Color fundus photograph
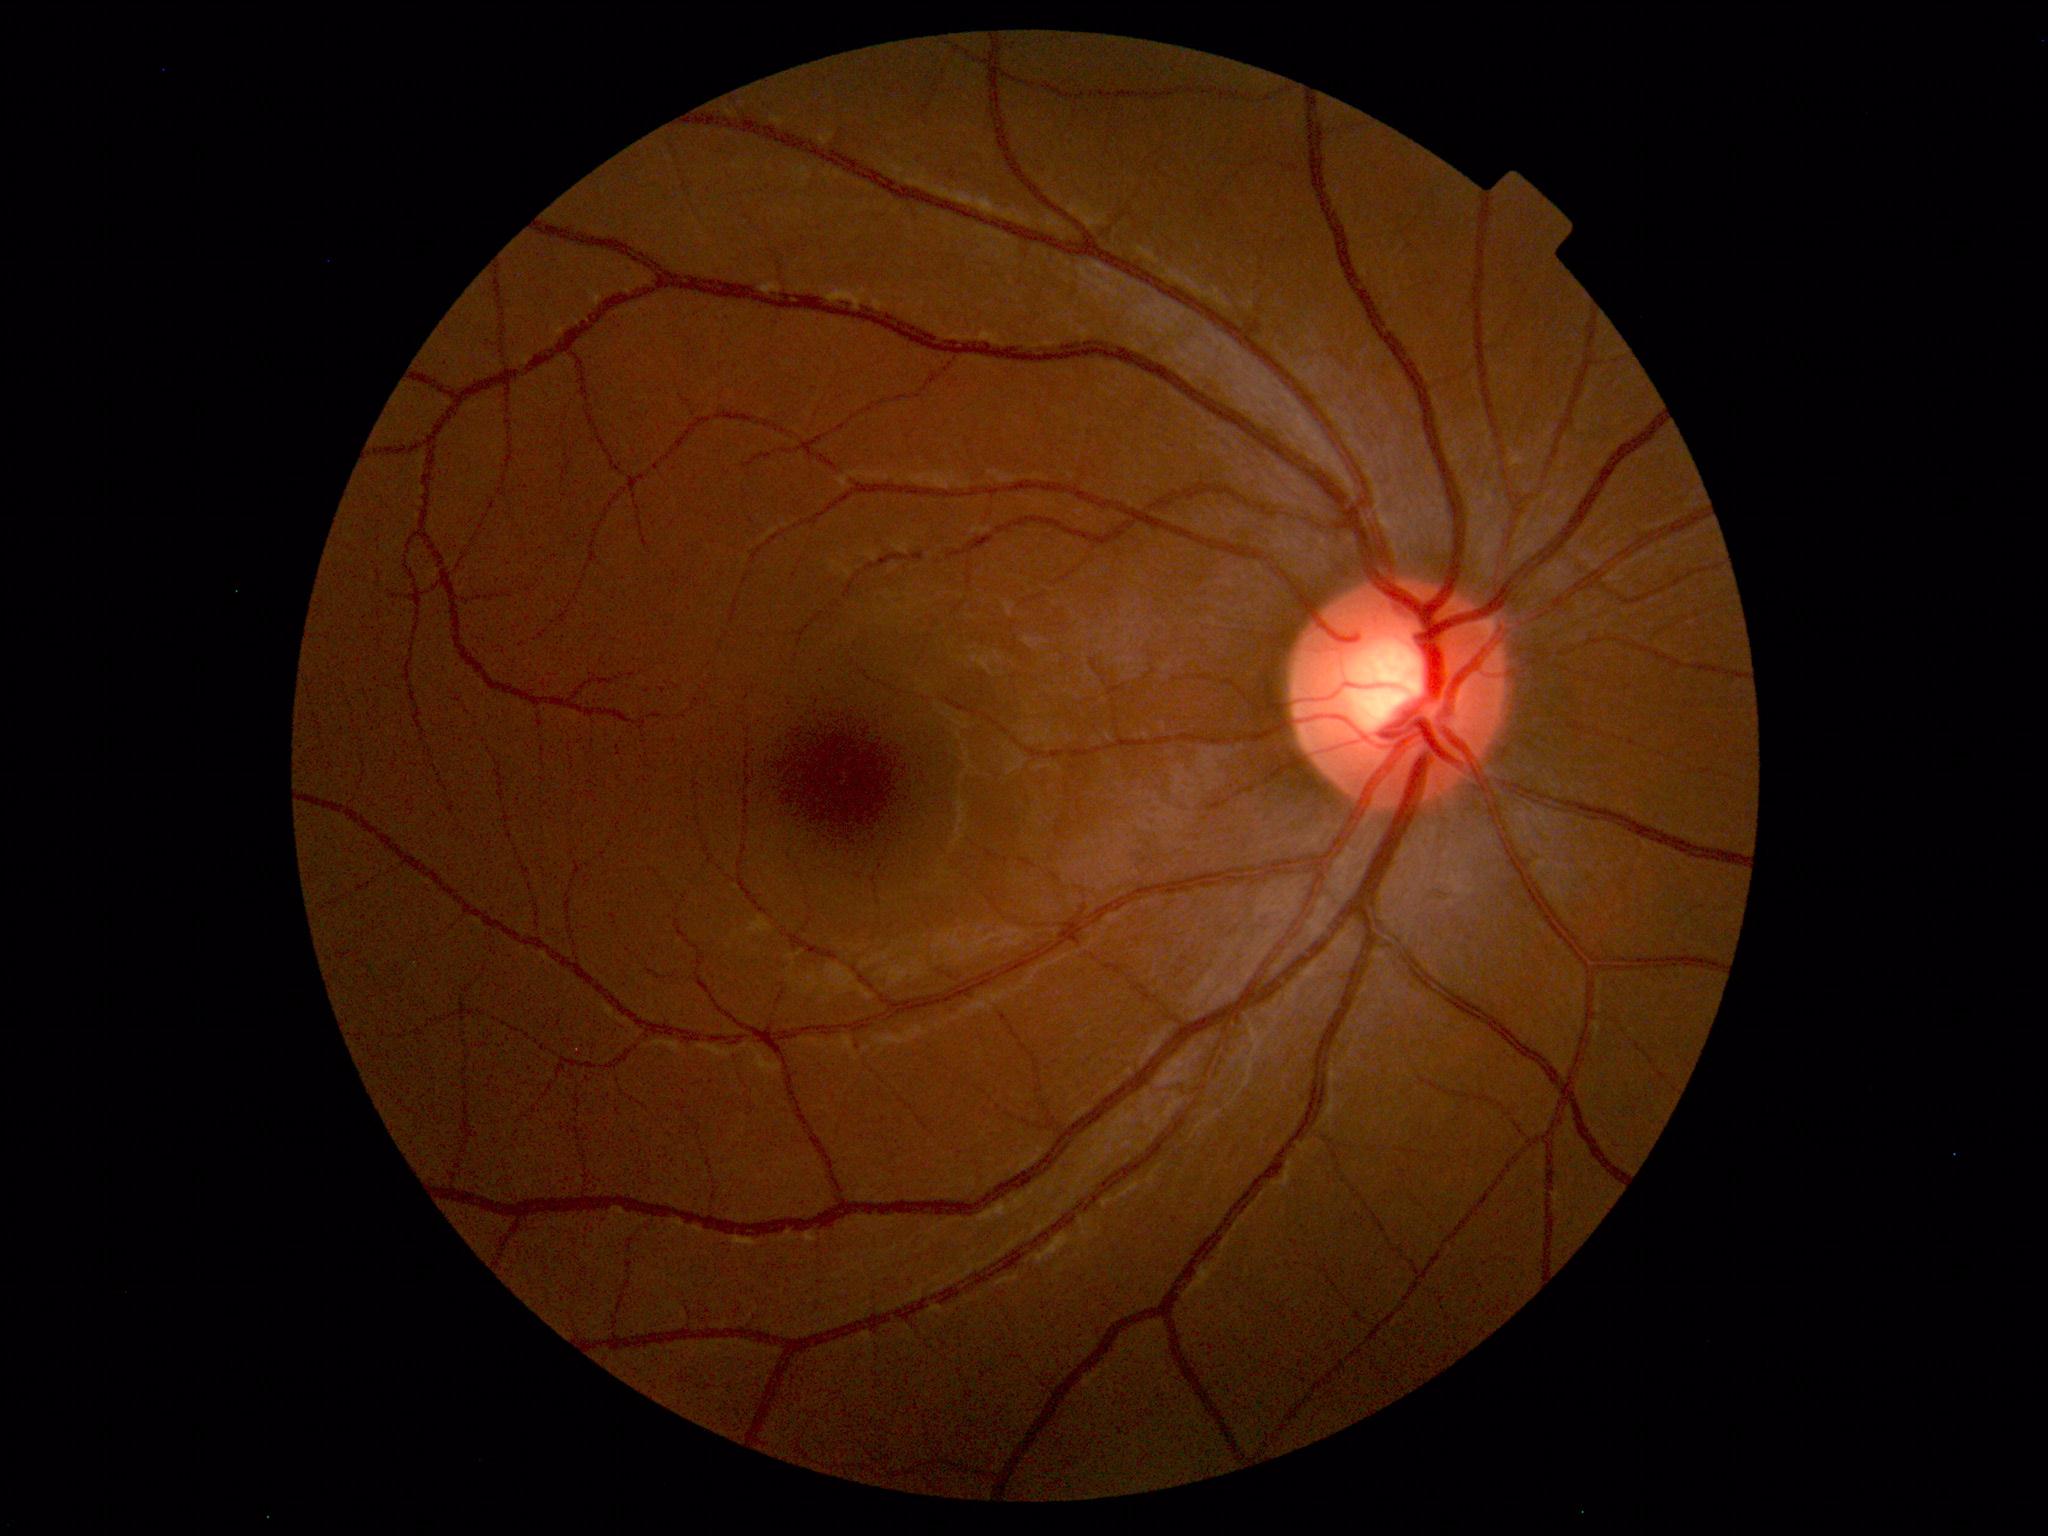
Within normal limits. No abnormalities identified.